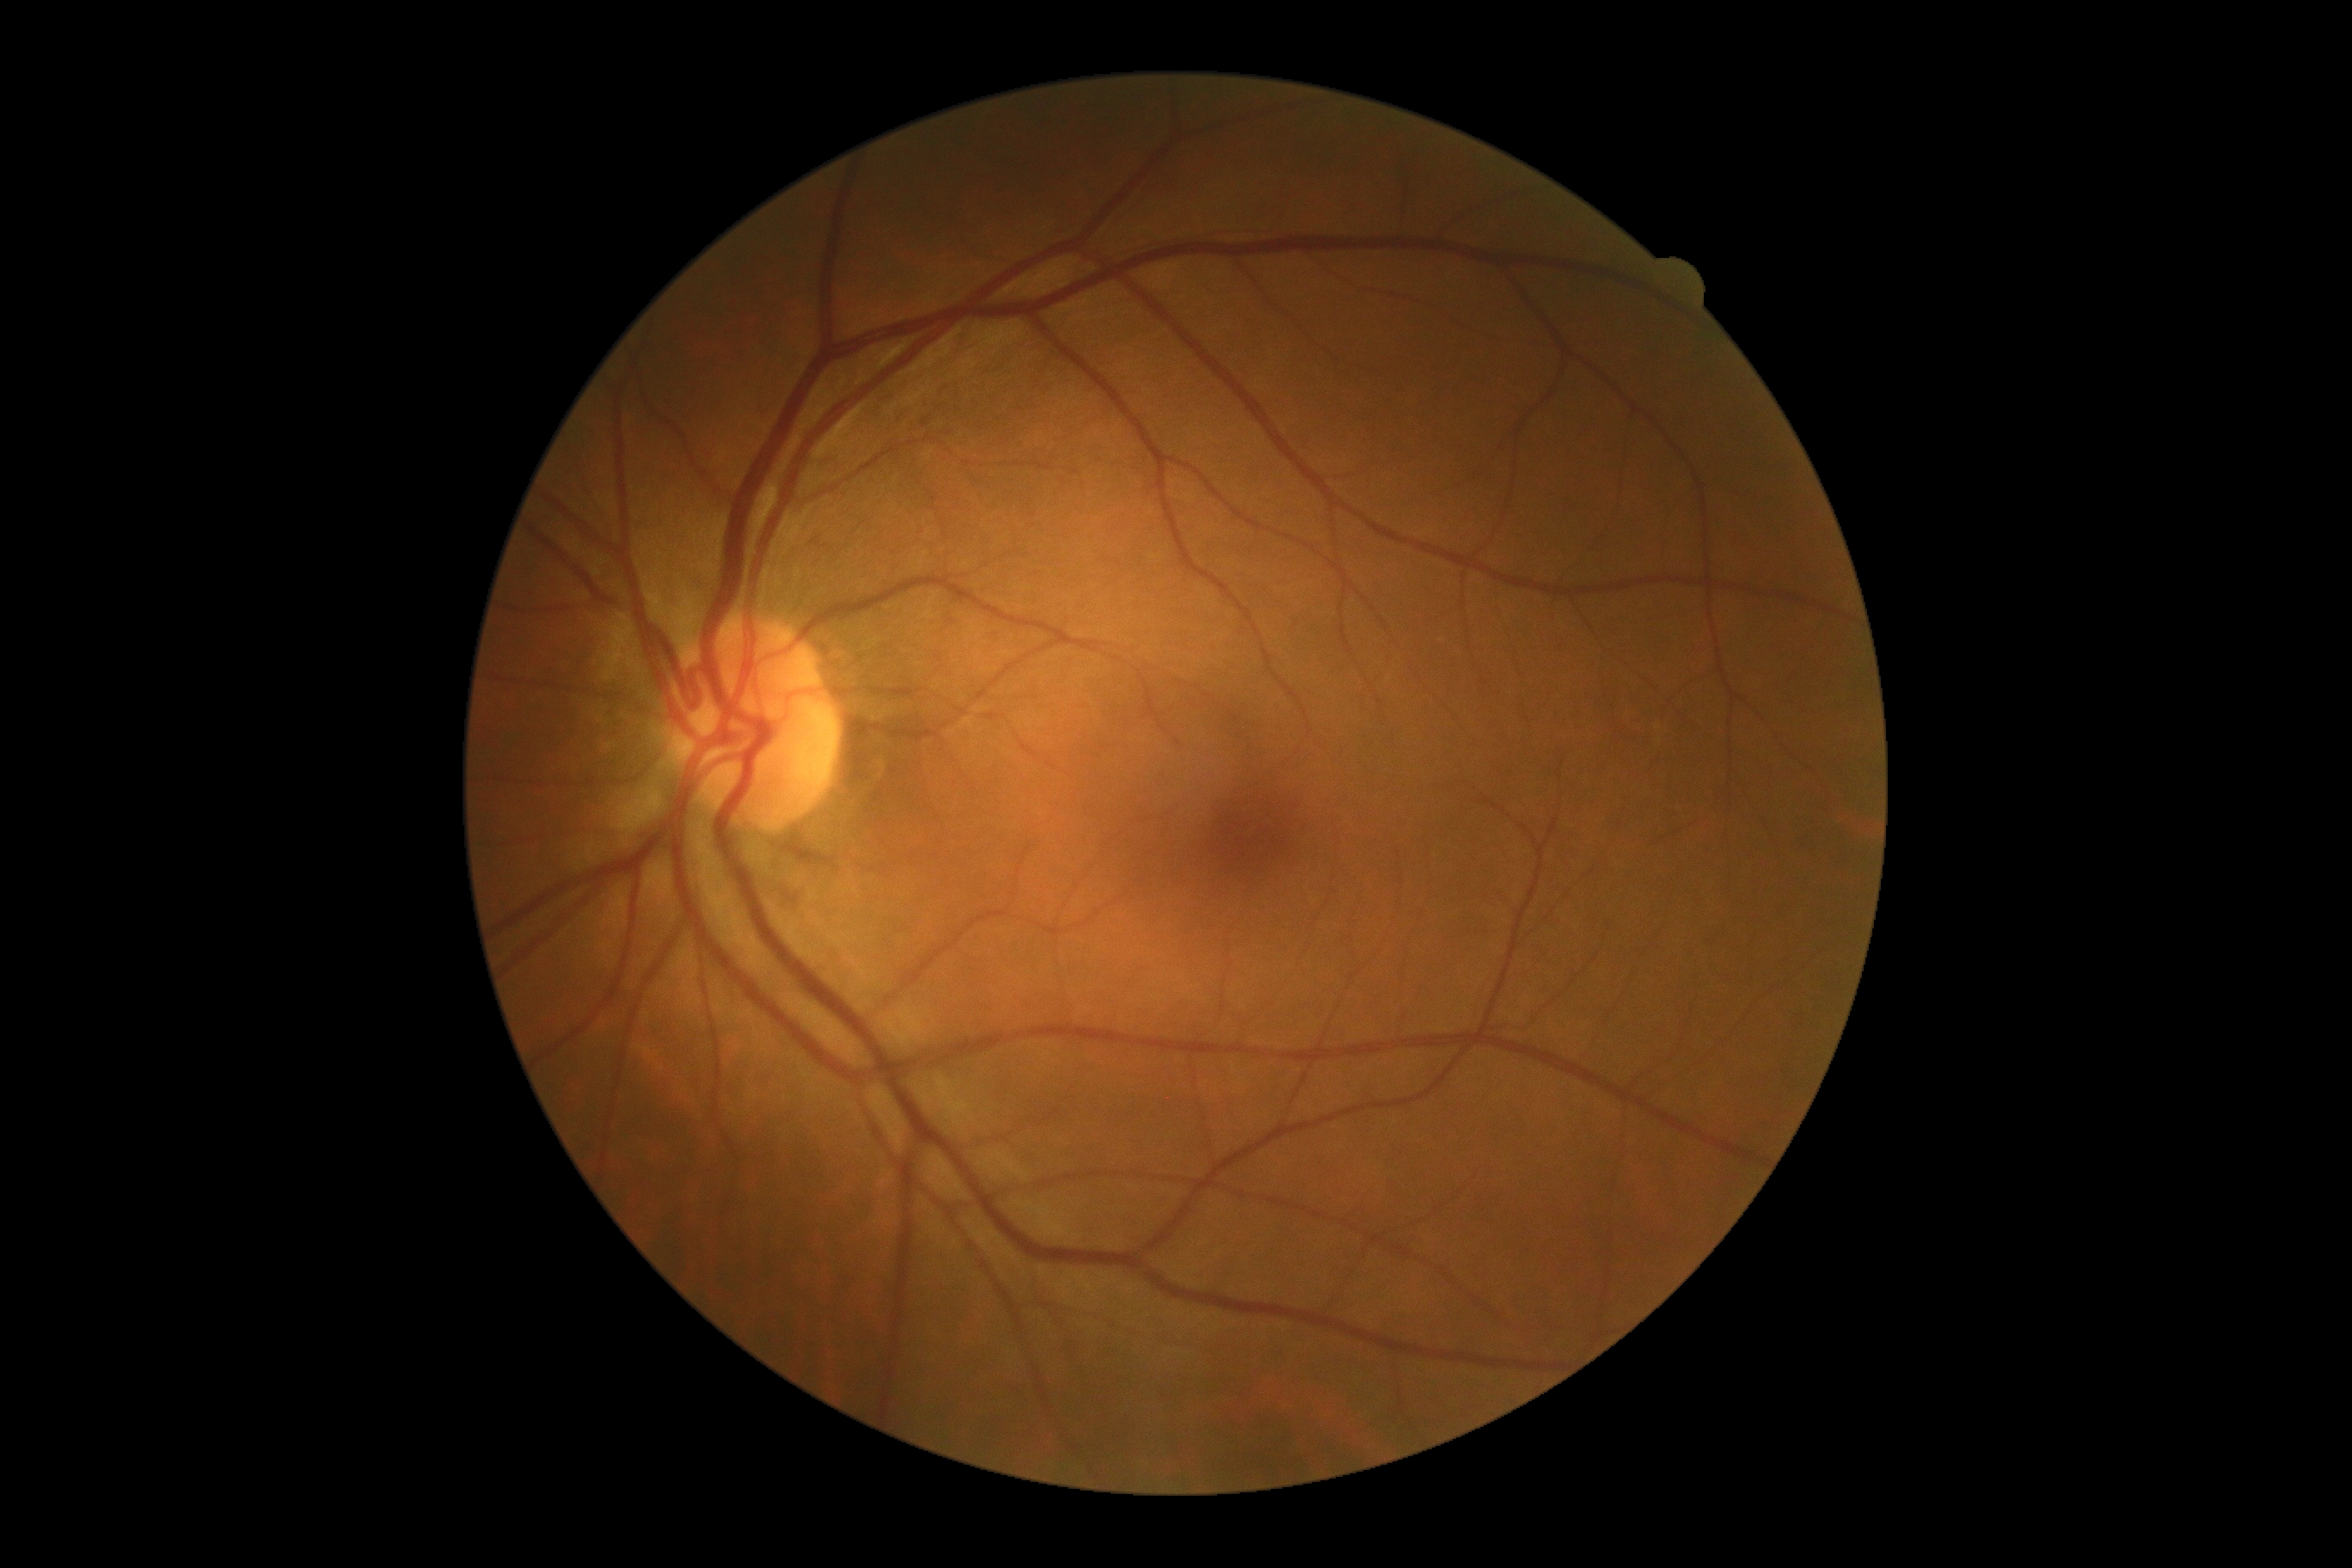
diabetic retinopathy (DR) = 0/4; DR impression = no apparent DR.